Color fundus photograph; image size 2212x1672; FOV: 45 degrees.
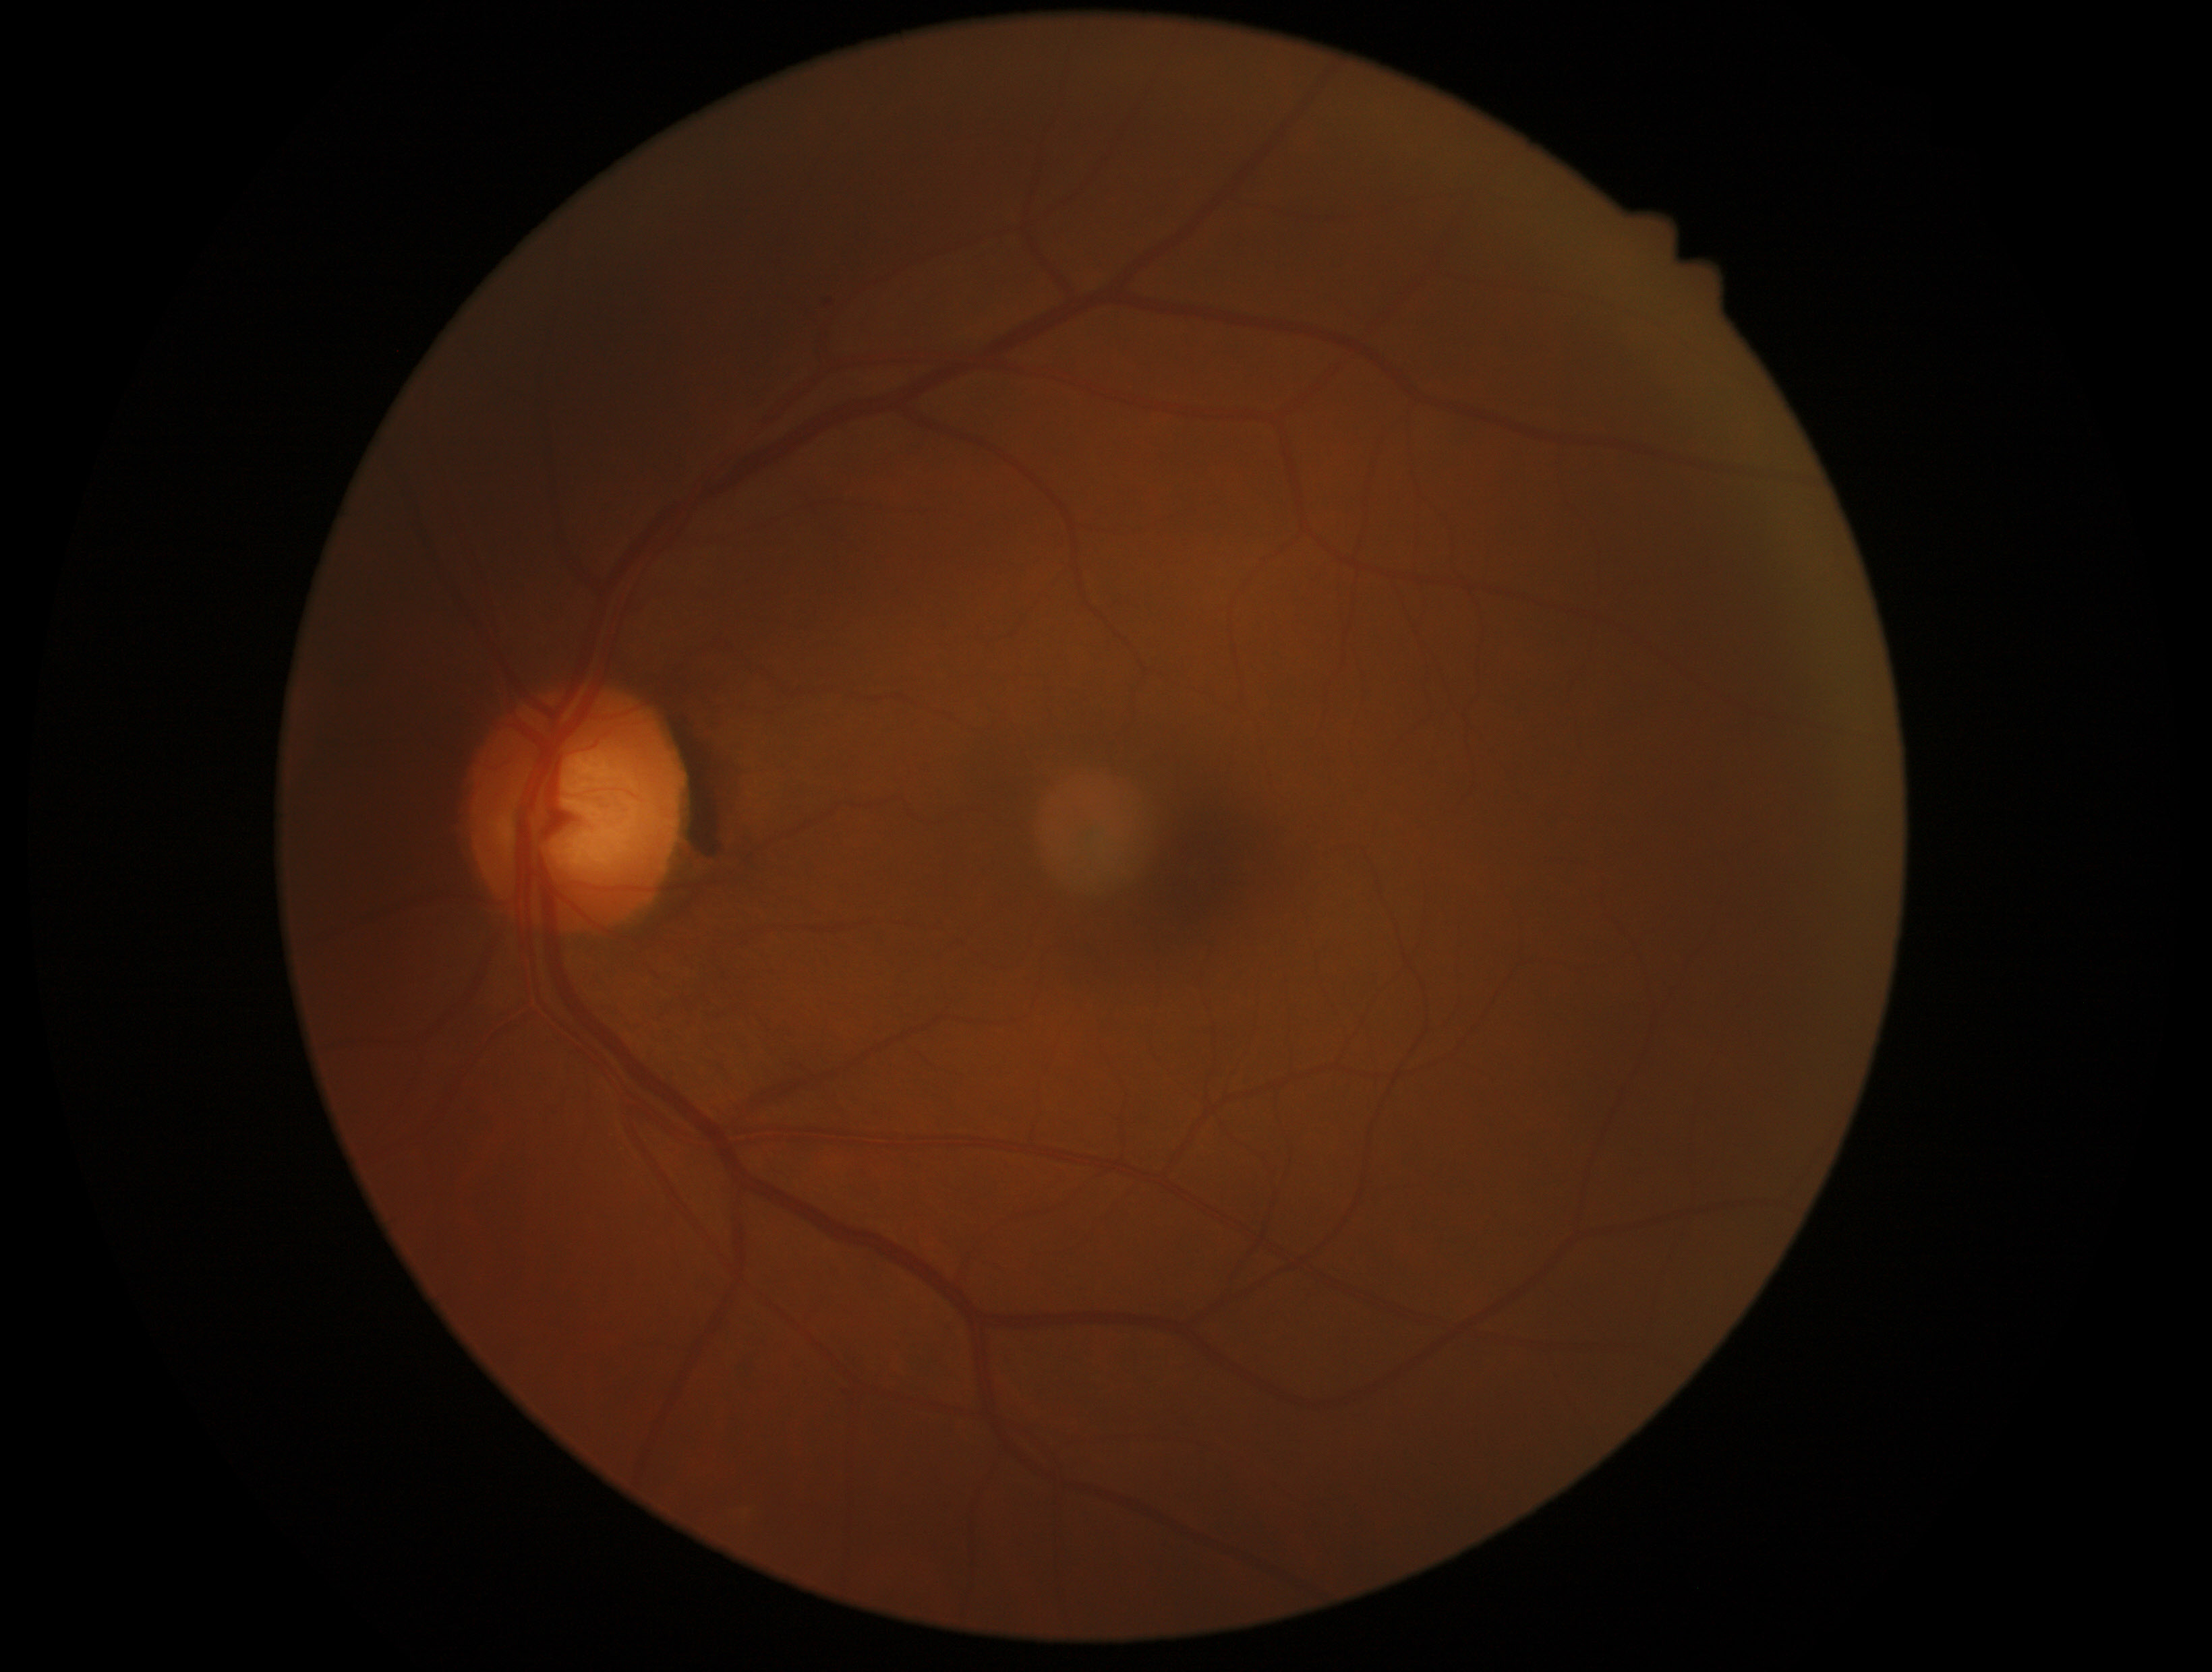

Diabetic retinopathy (DR): grade 0 (no apparent retinopathy) — no visible signs of diabetic retinopathy.